Pediatric retinal photograph (wide-field): 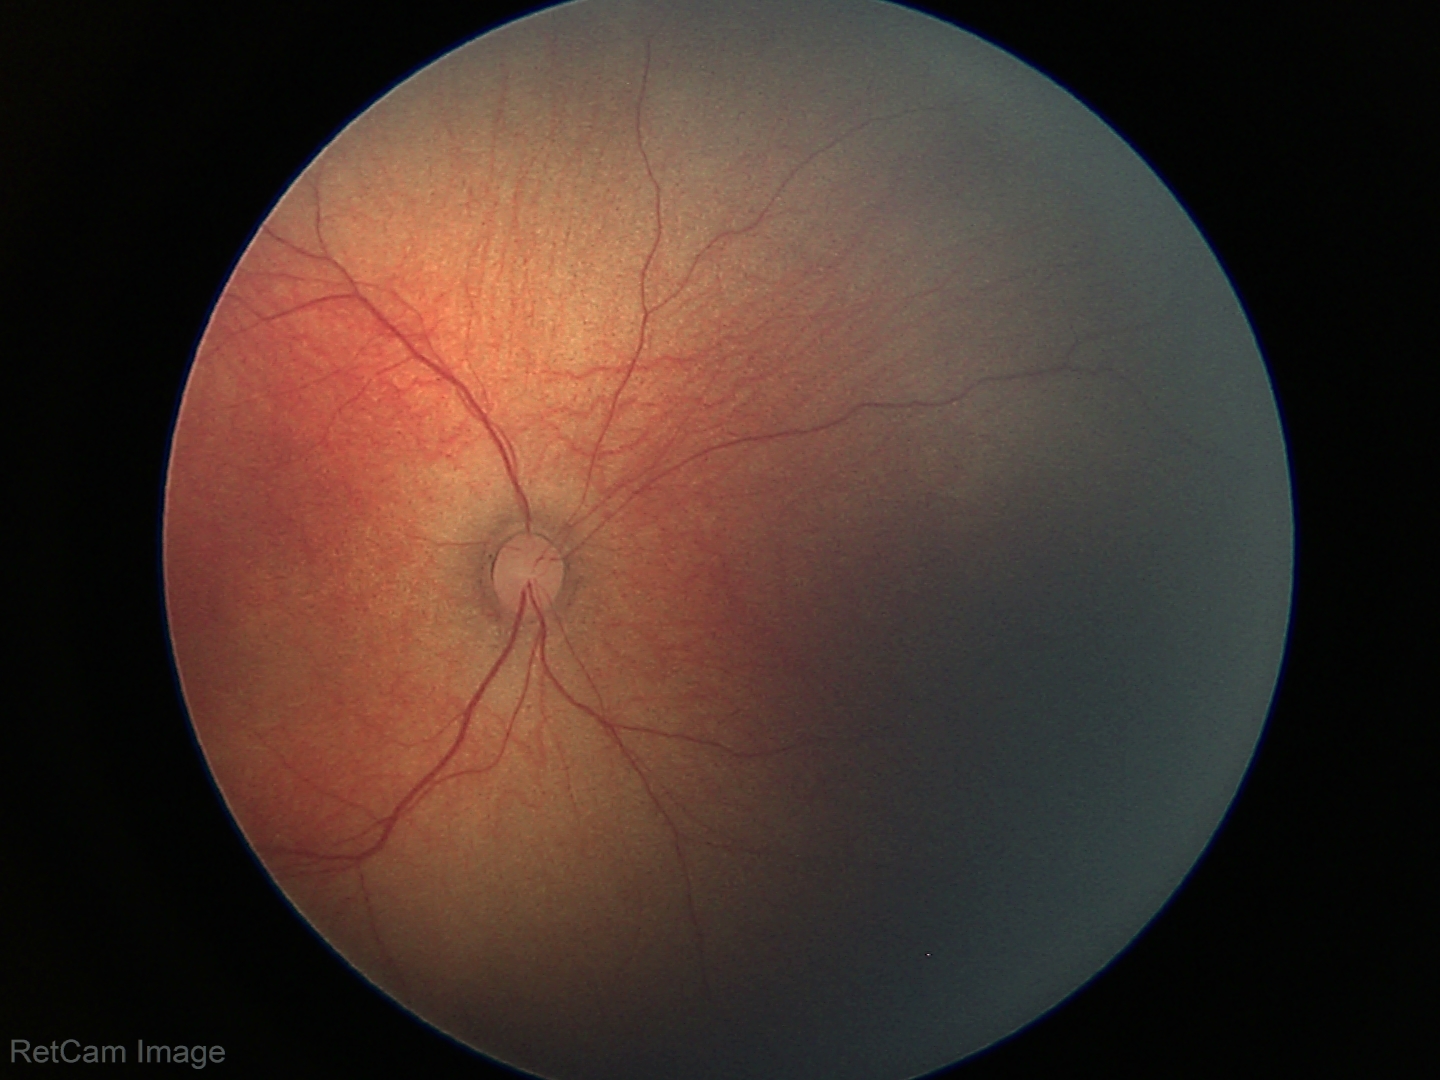 Screening examination with no abnormal retinal findings.